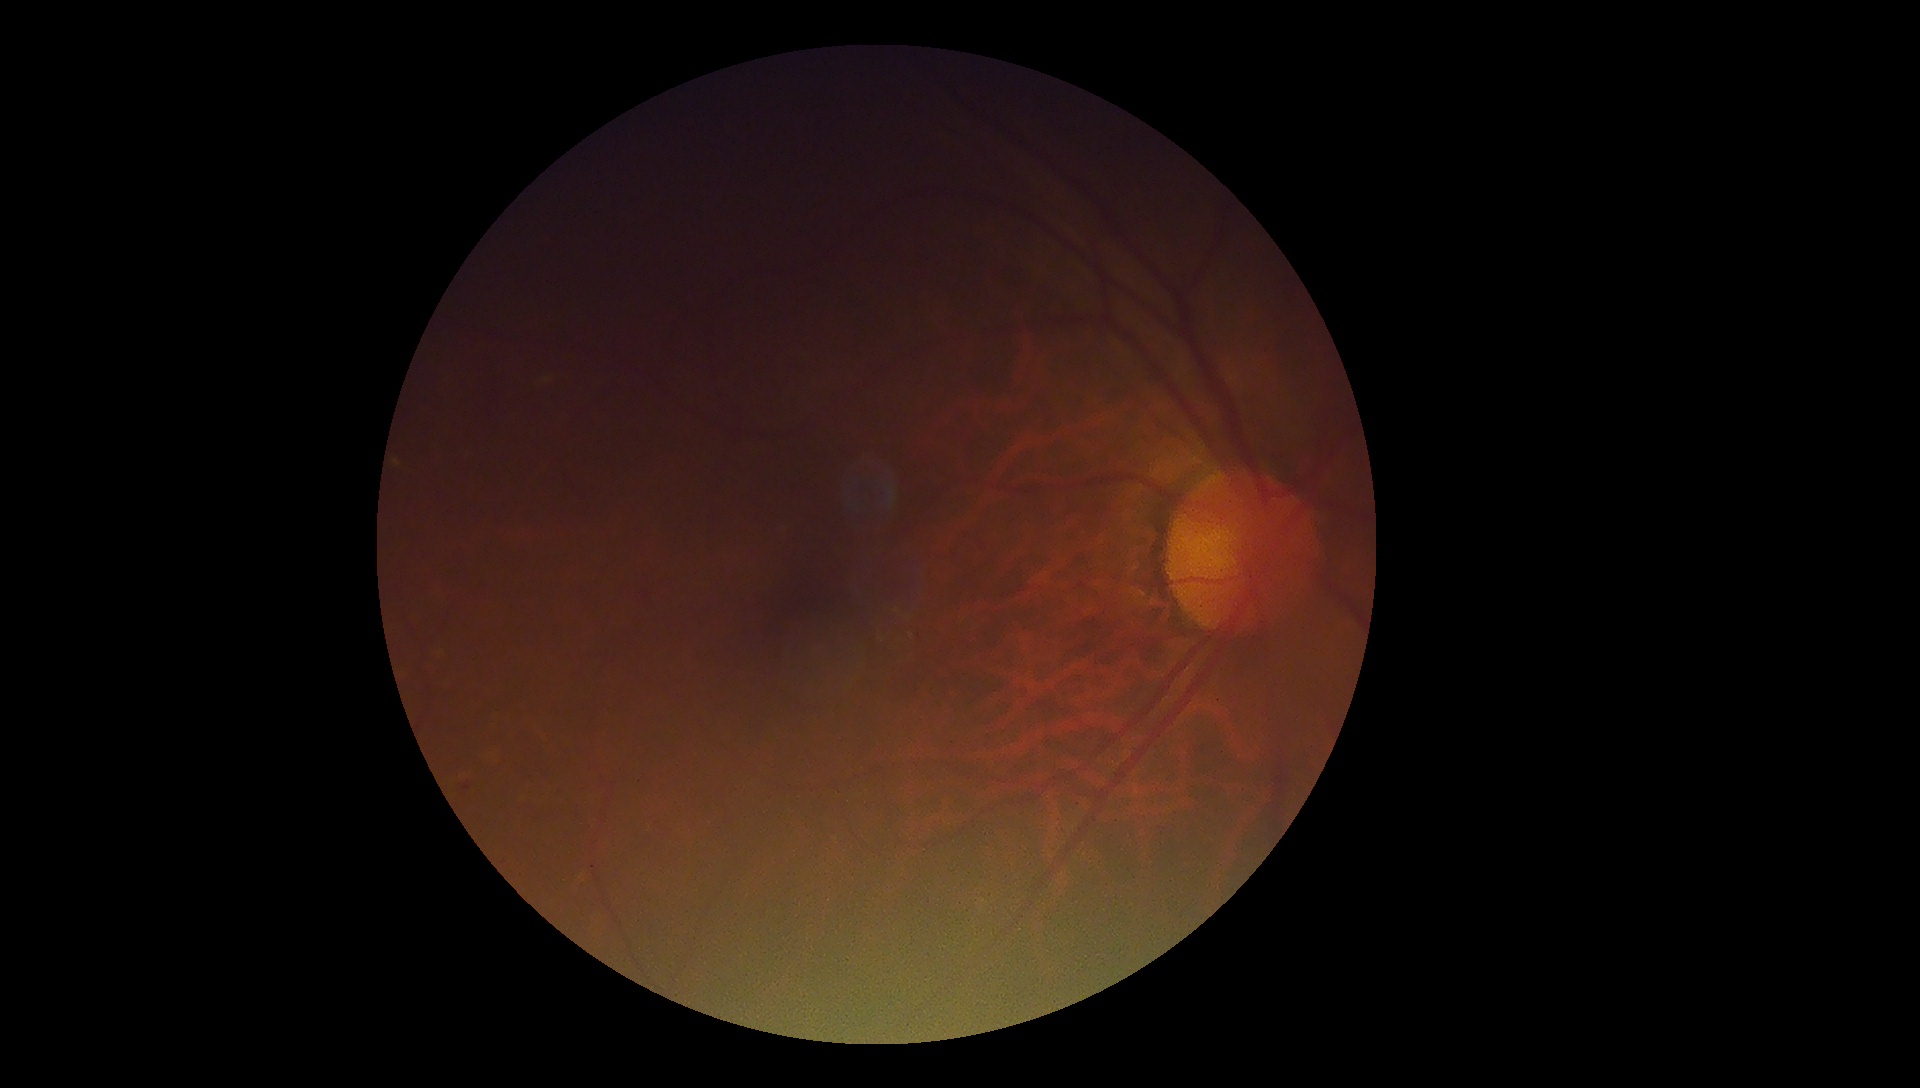 DR severity: mild NPDR (grade 1), DR class: non-proliferative diabetic retinopathy.